1659 x 2212 pixels; color fundus photograph
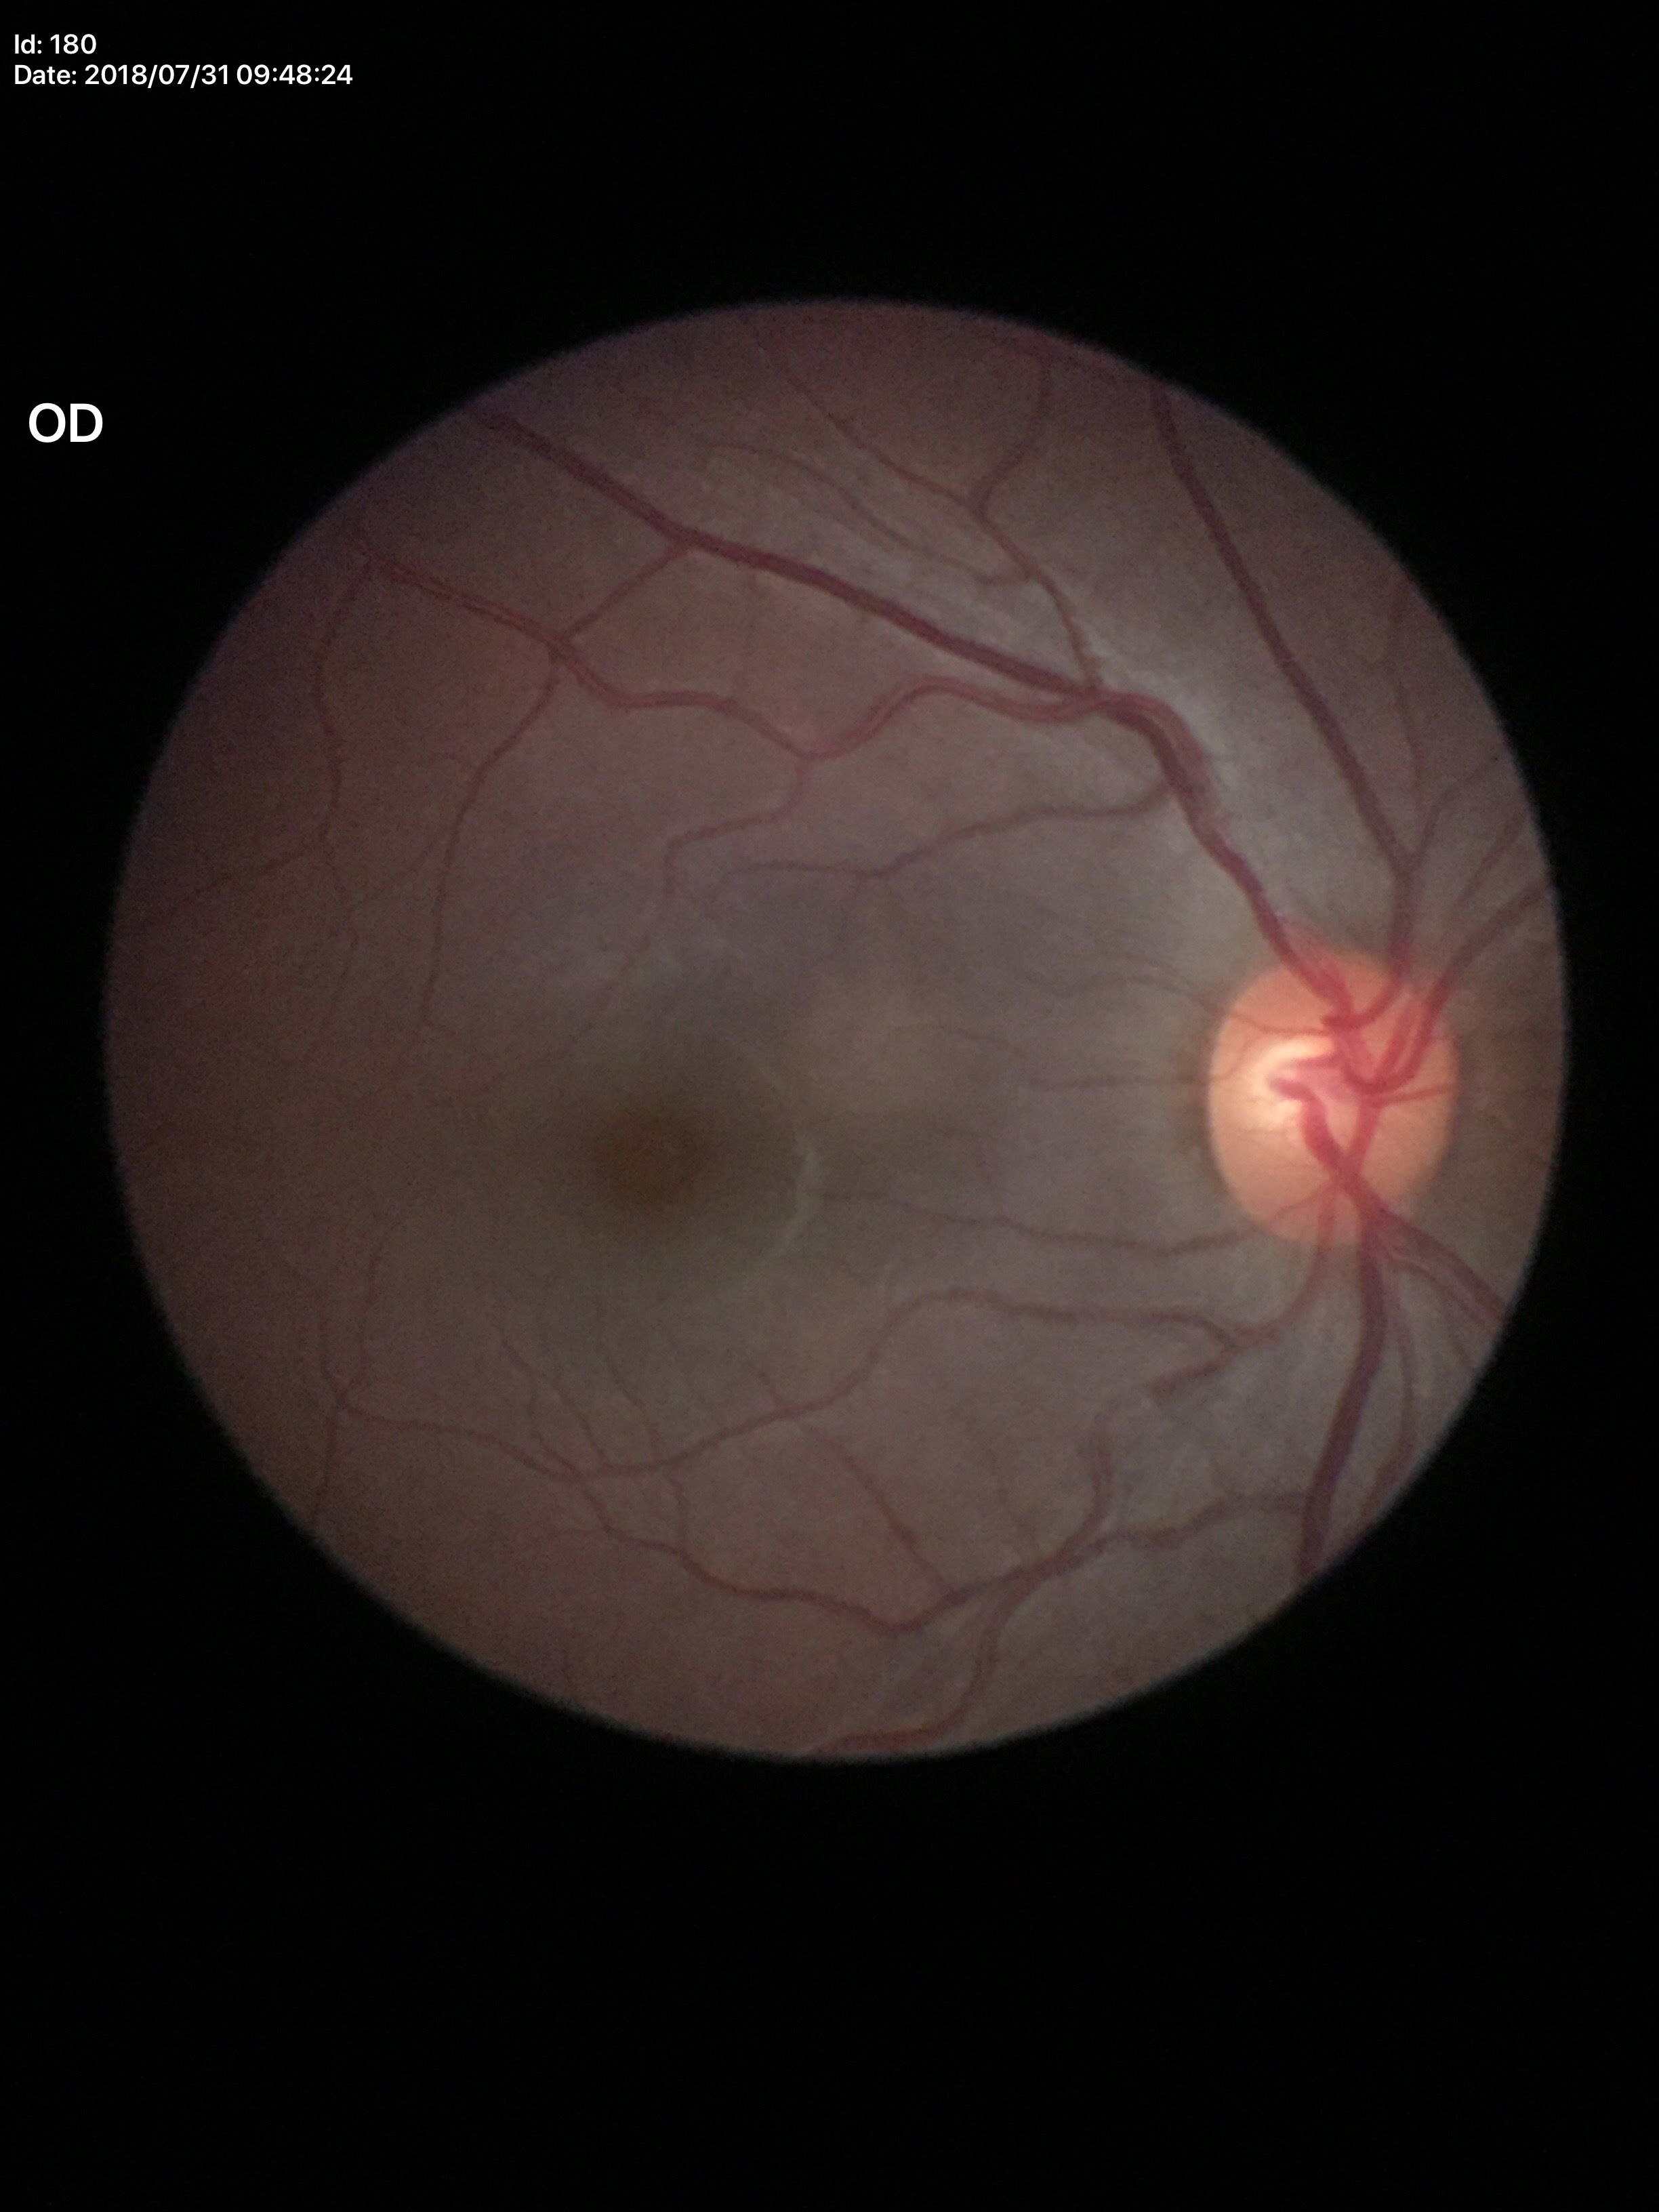

Glaucoma impression=negative
horizontal cup-to-disc ratio (HCDR)=0.60
vertical C/D ratio (VCDR)=0.50